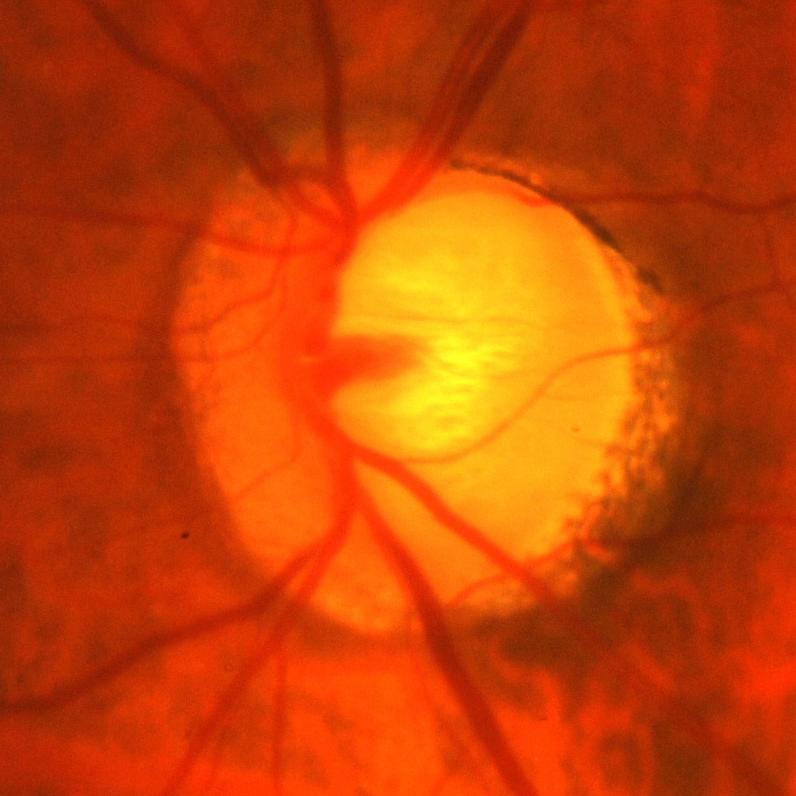

Glaucomatous changes.